Nonmydriatic fundus photograph, FOV: 45 degrees.
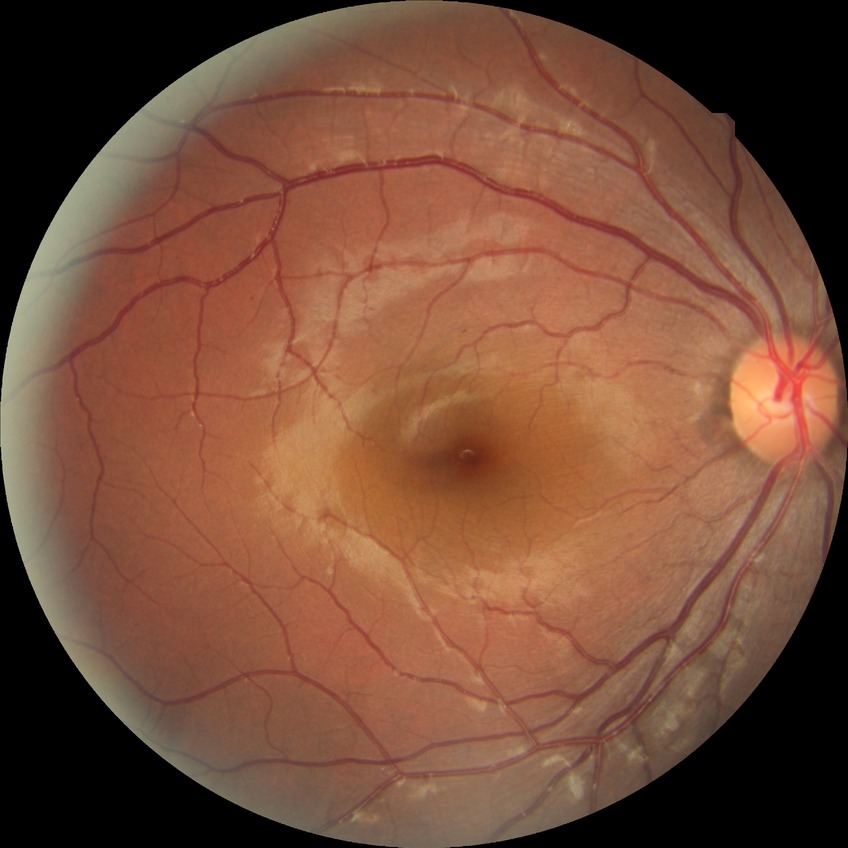 DR is NDR.